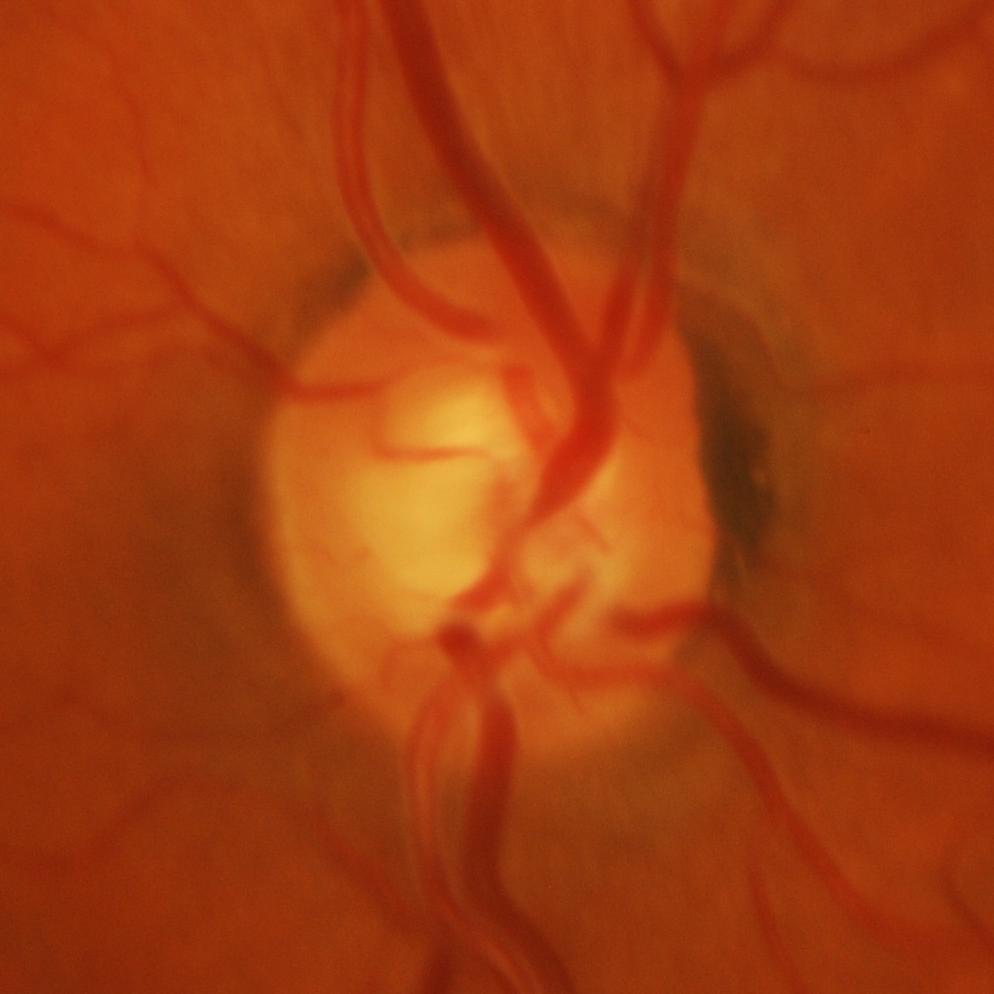
Glaucoma is present. Showing glaucoma.